45-degree field of view — 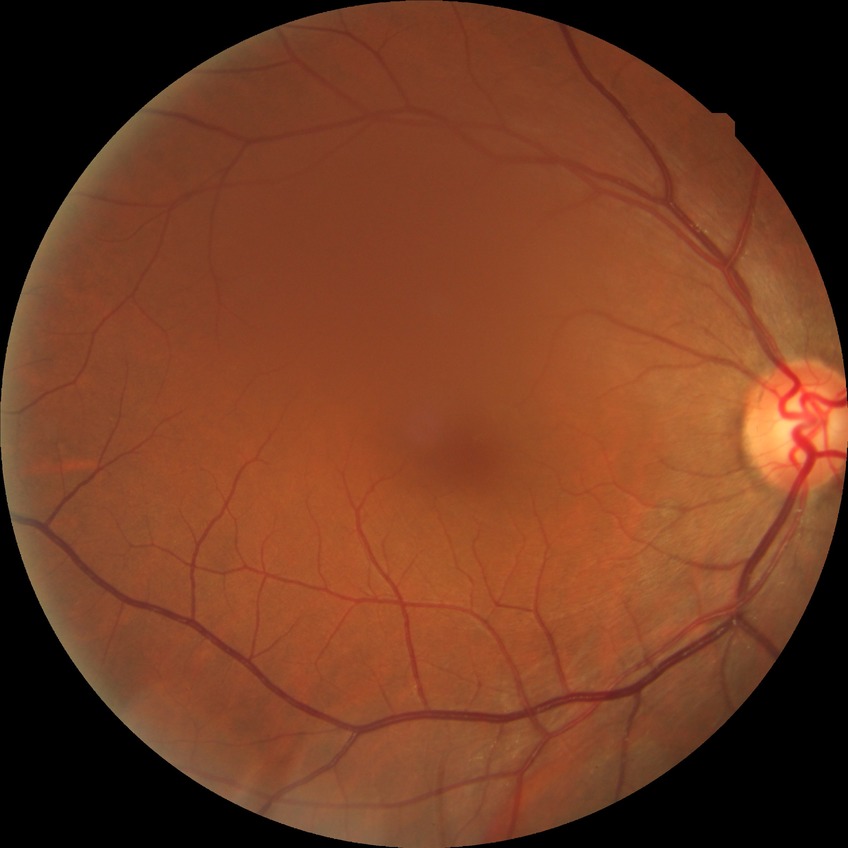

Diabetic retinopathy (DR): no diabetic retinopathy (NDR).